Ultra-widefield (UWF) fundus image: 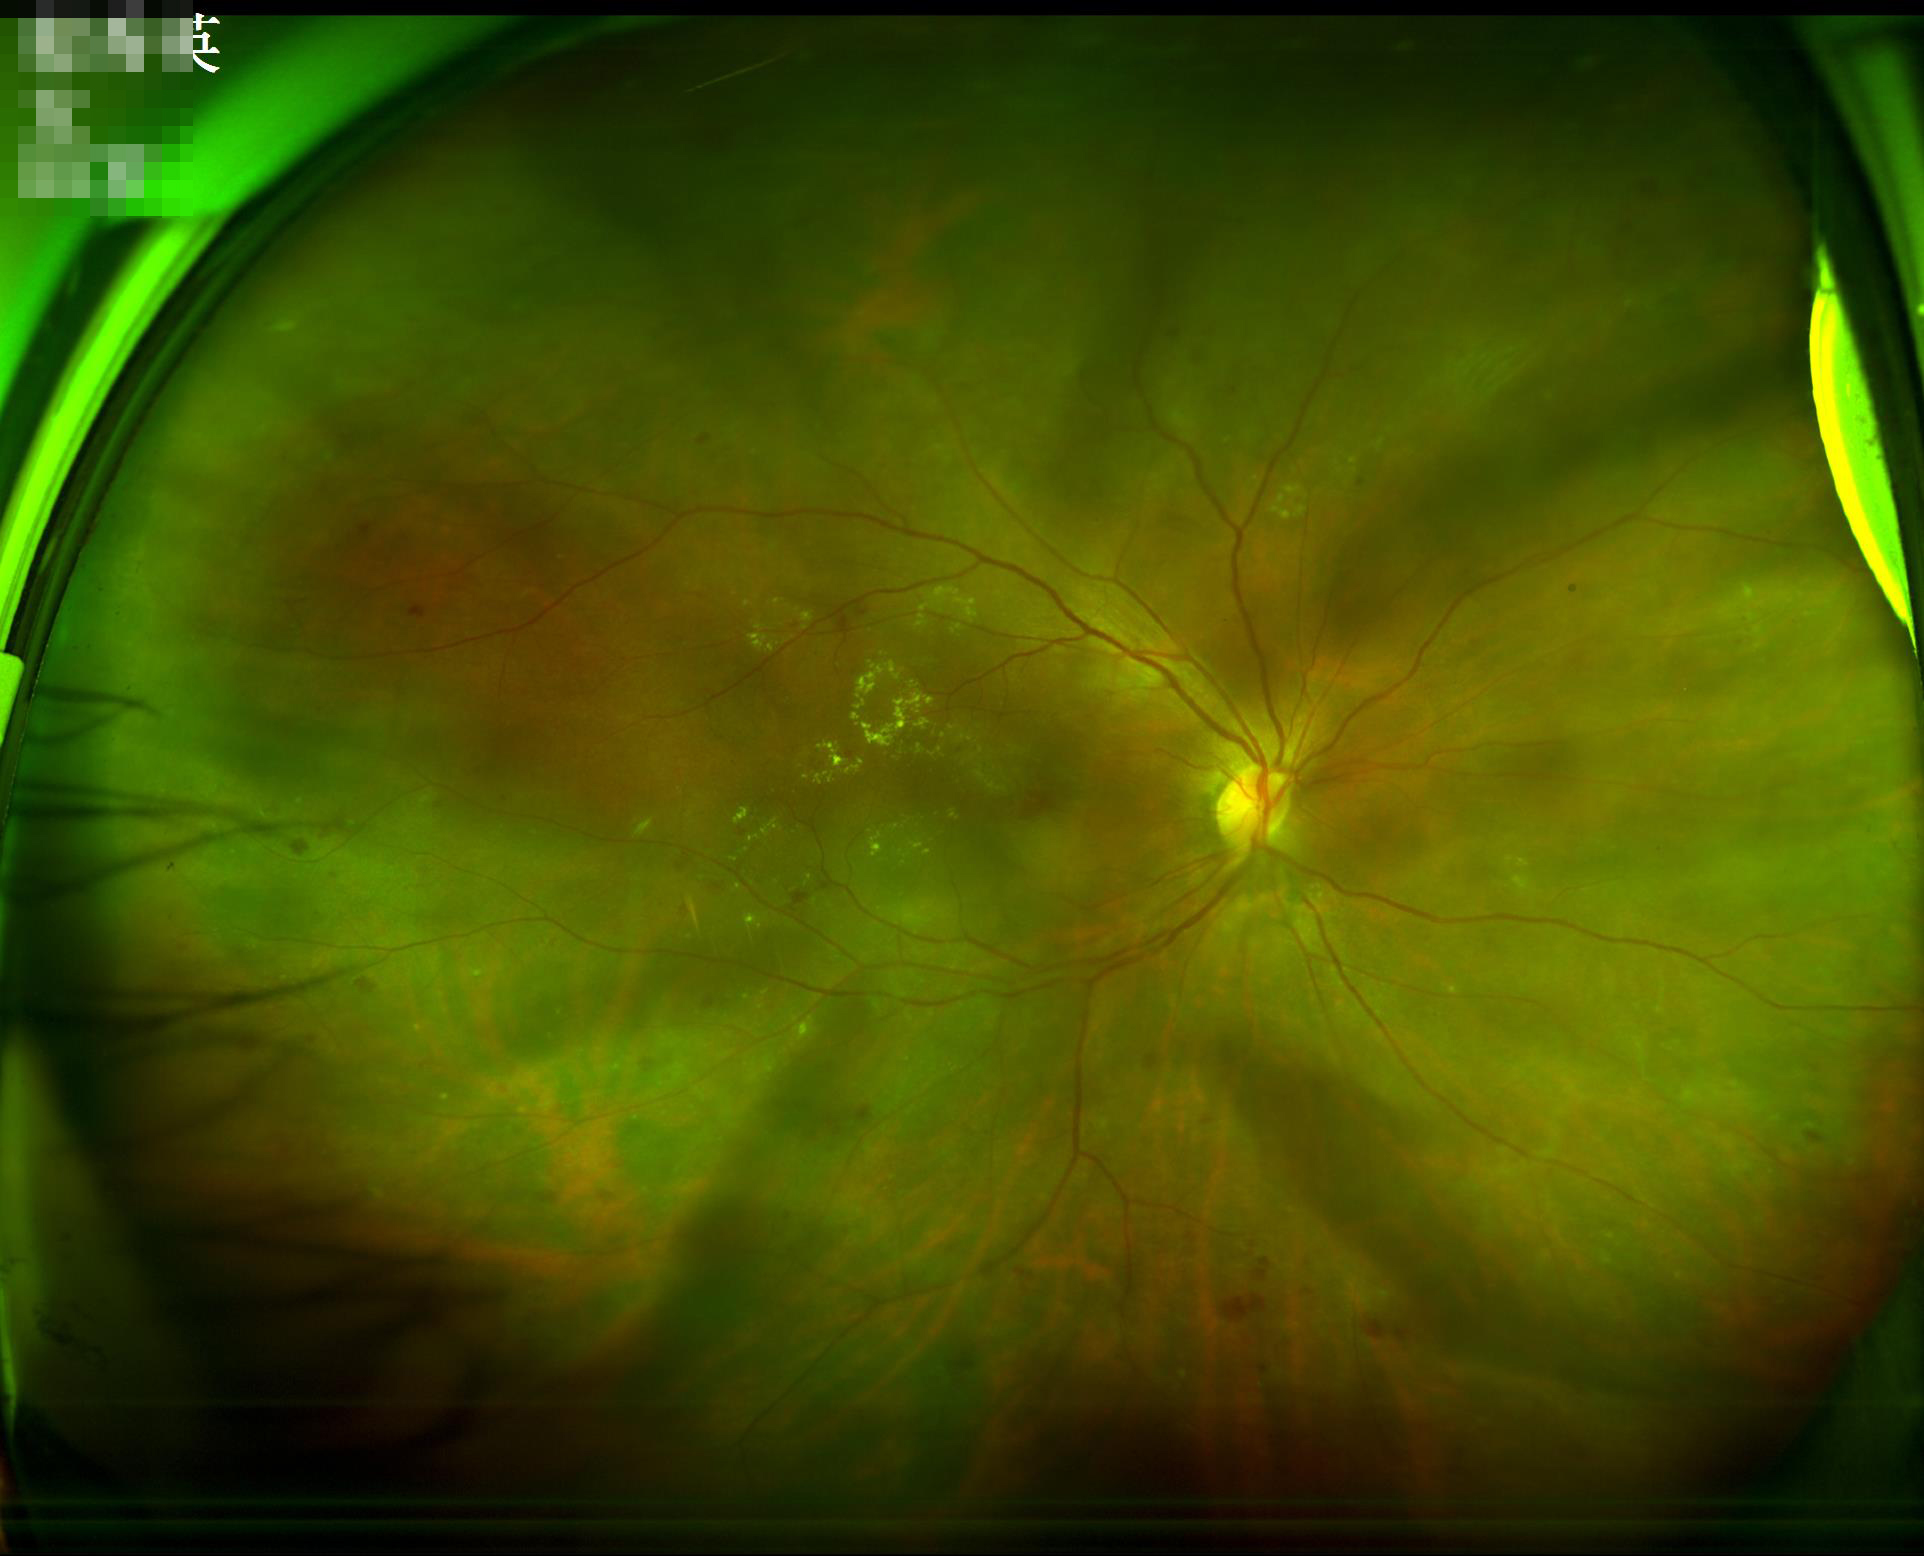
Image quality is adequate for diagnostic use. Illumination is uneven. Optic disc, vessels, and background are in focus. Good dynamic range.